FOV: 45 degrees, CFP, 2048x1536
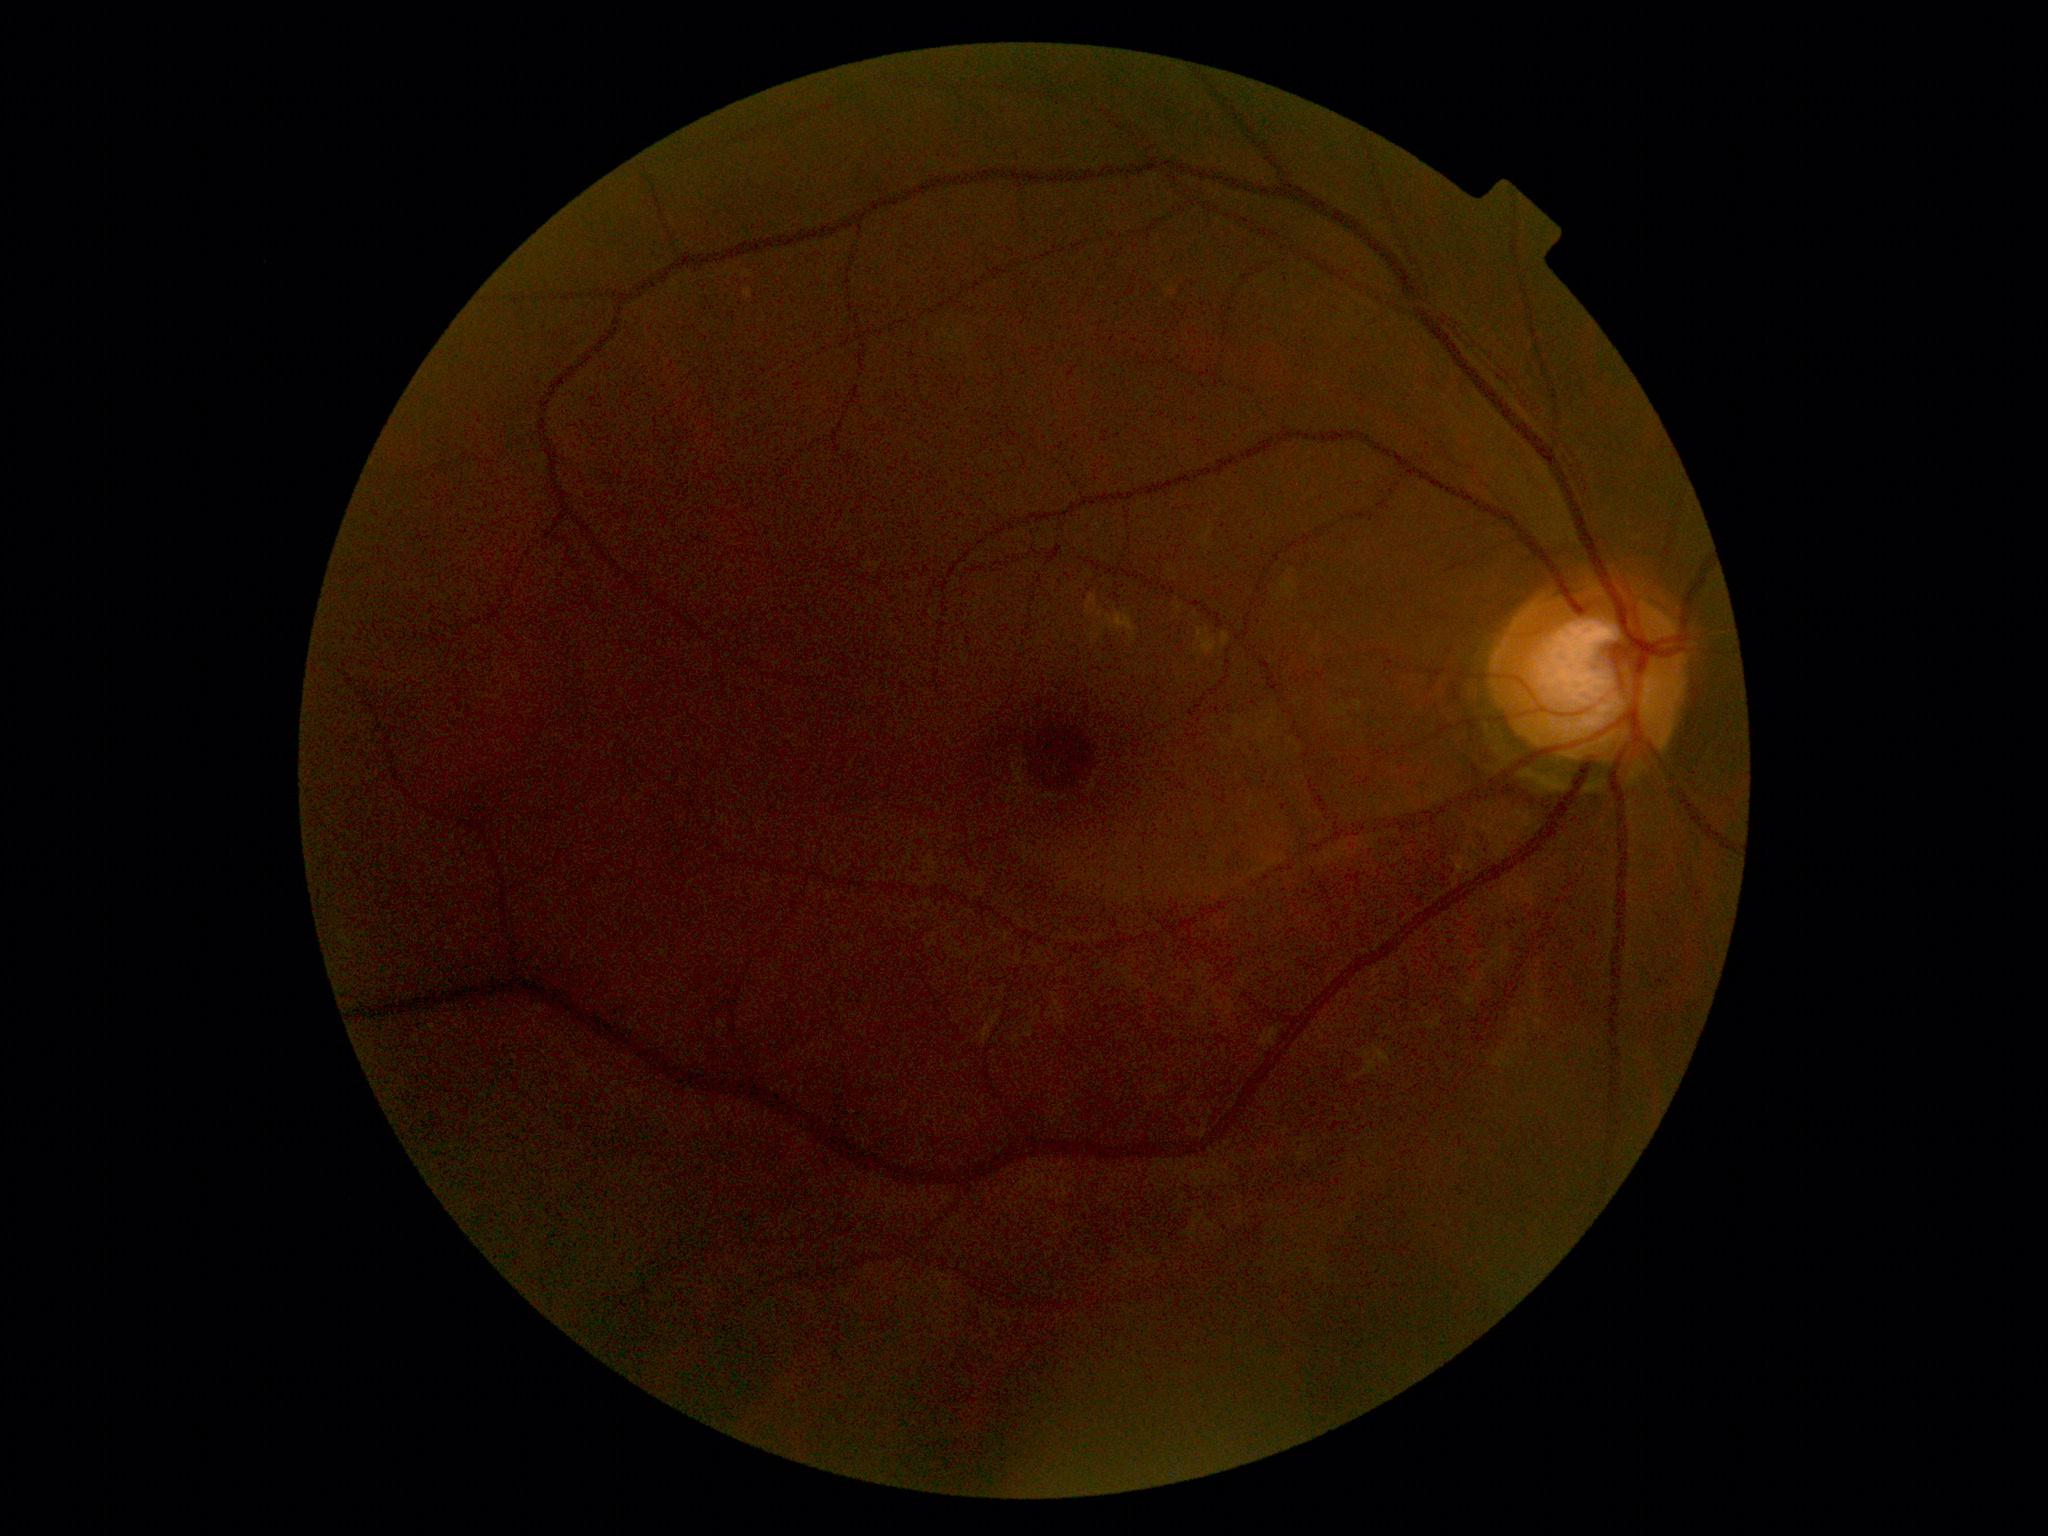

DR: 0.